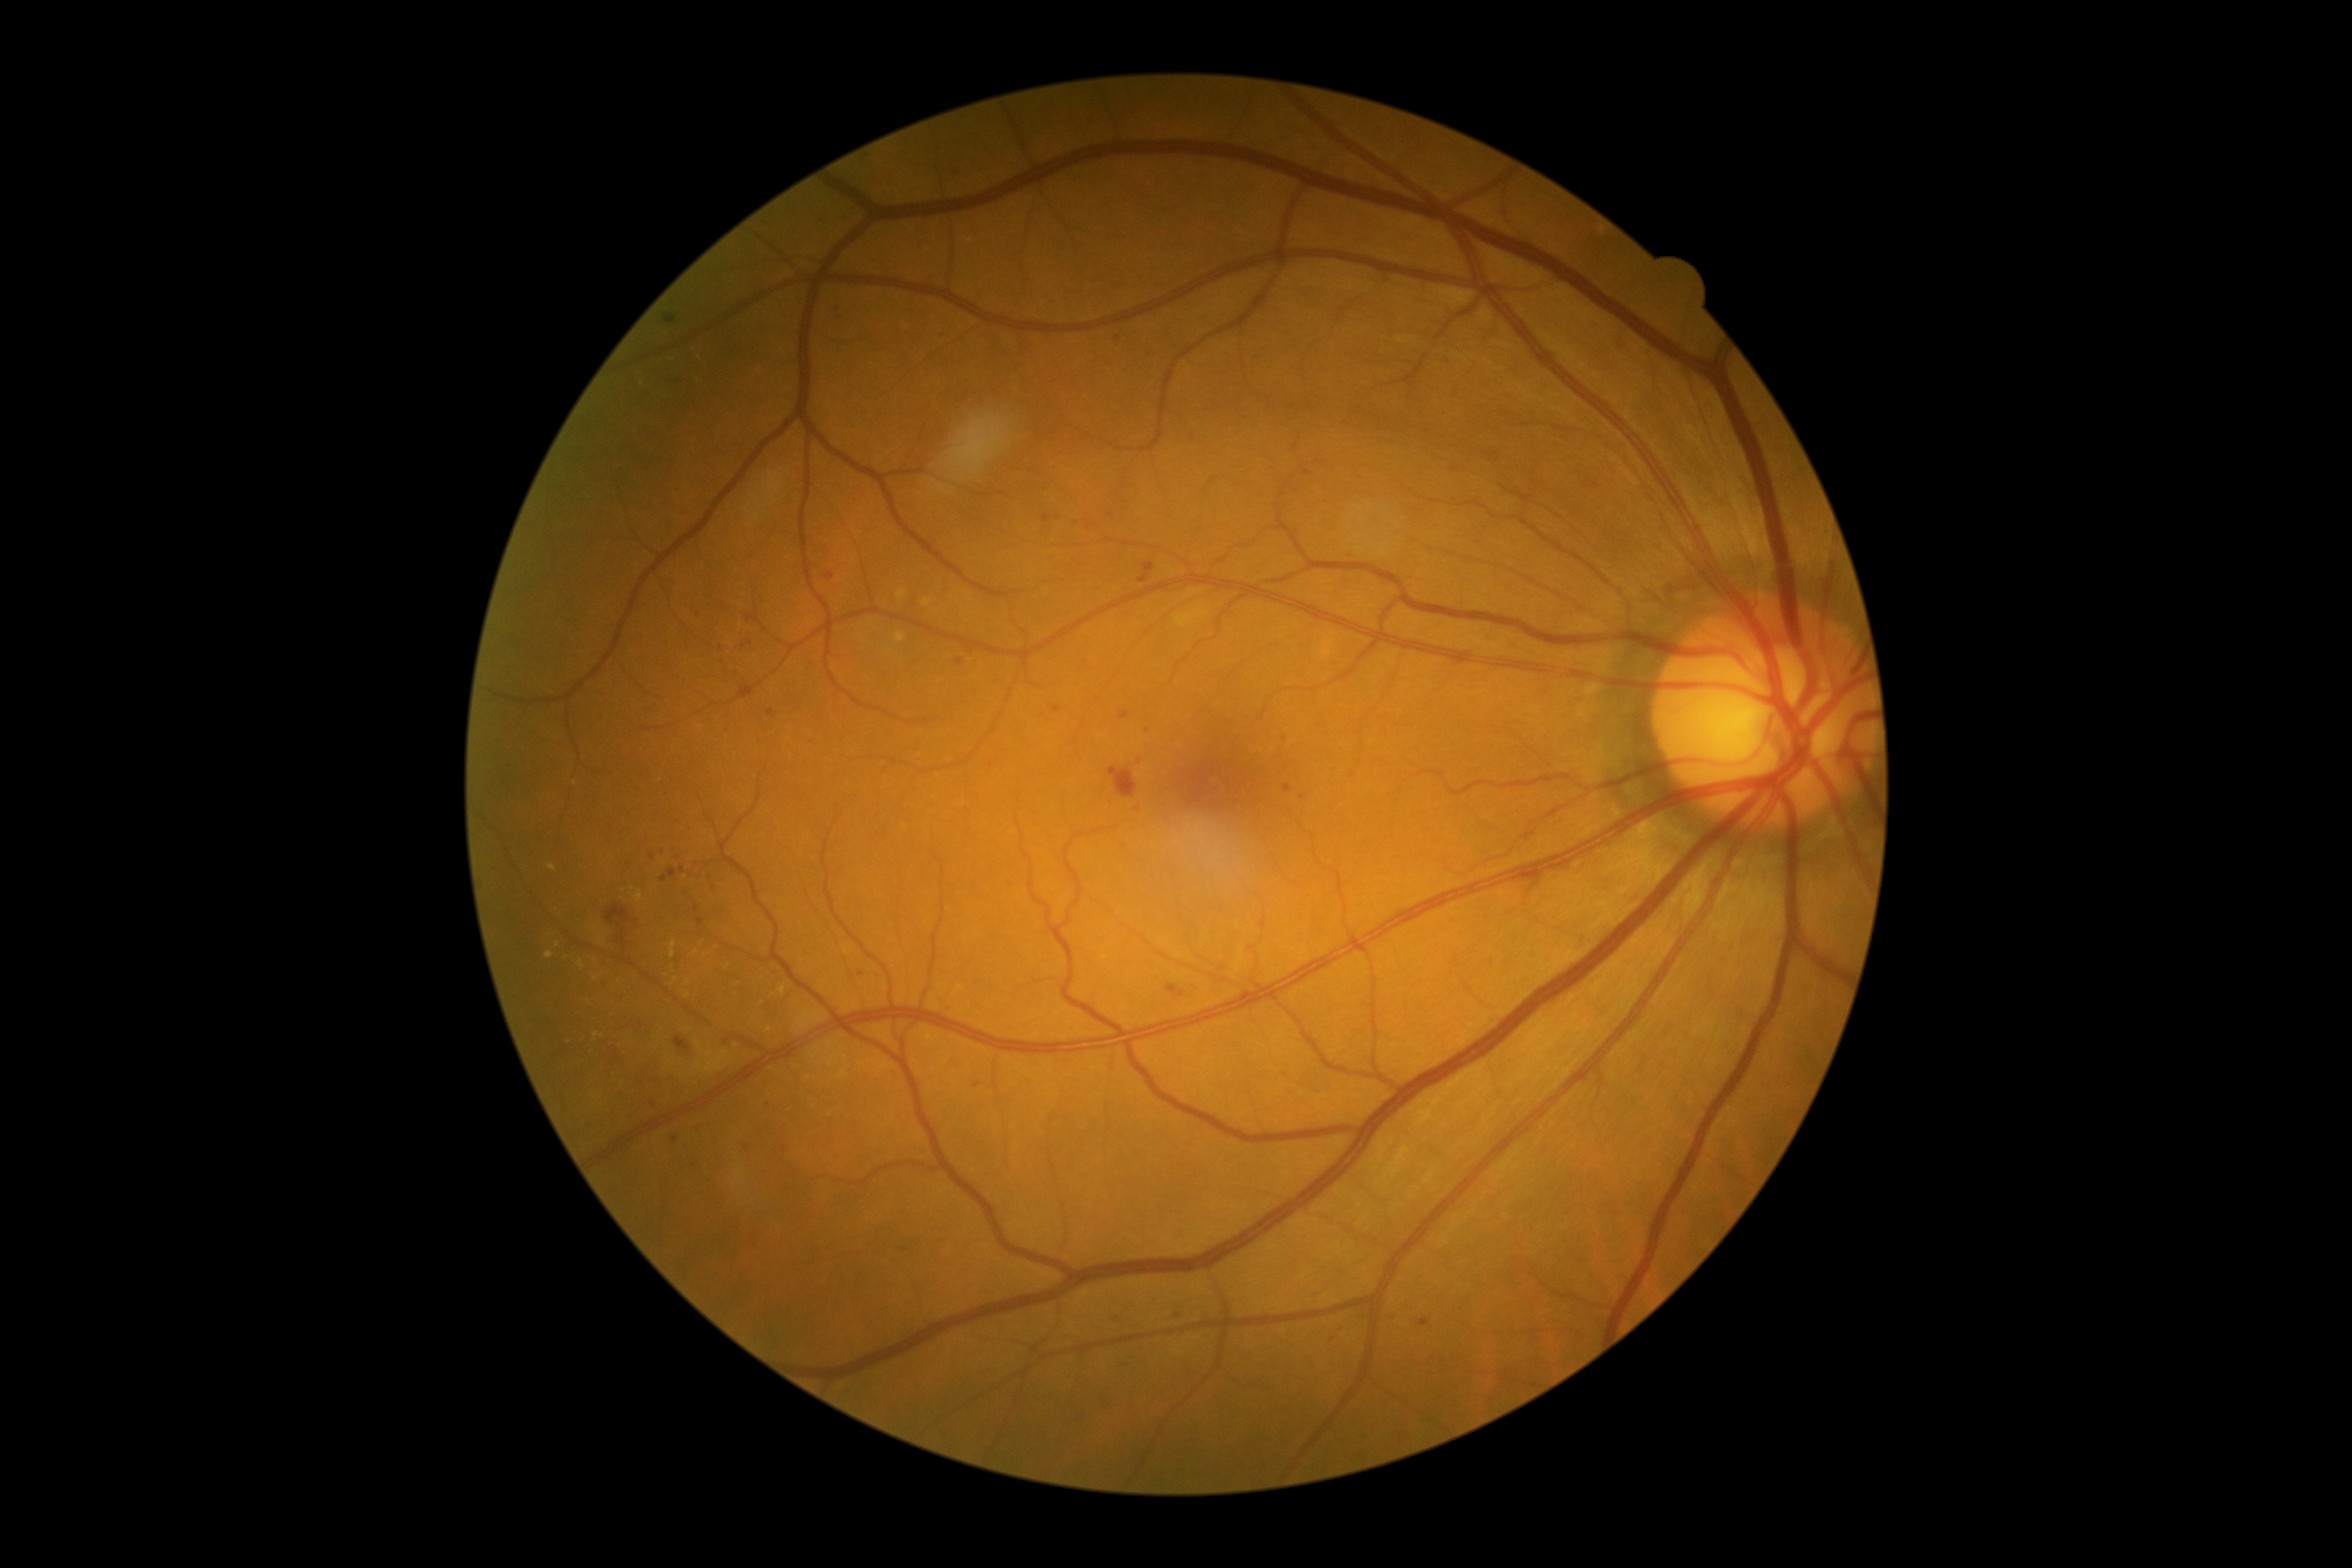
Diabetic retinopathy (DR) is 2 — more than just microaneurysms but less than severe NPDR
Selected lesions:
microaneurysms (MAs) (subset): bbox(613, 1057, 622, 1062) | bbox(721, 852, 725, 862) | bbox(1419, 1320, 1430, 1326) | bbox(972, 1082, 981, 1089) | bbox(826, 573, 835, 582) | bbox(1120, 713, 1130, 721) | bbox(661, 867, 677, 883)
MAs (small, approximate centers) near x=749 y=643 | x=675 y=1140 | x=707 y=865 | x=621 y=998 | x=838 y=308 | x=1056 y=709 | x=721 y=649 | x=904 y=1250 | x=1306 y=472 | x=654 y=1105 | x=1139 y=761 | x=698 y=908